Woman patient.
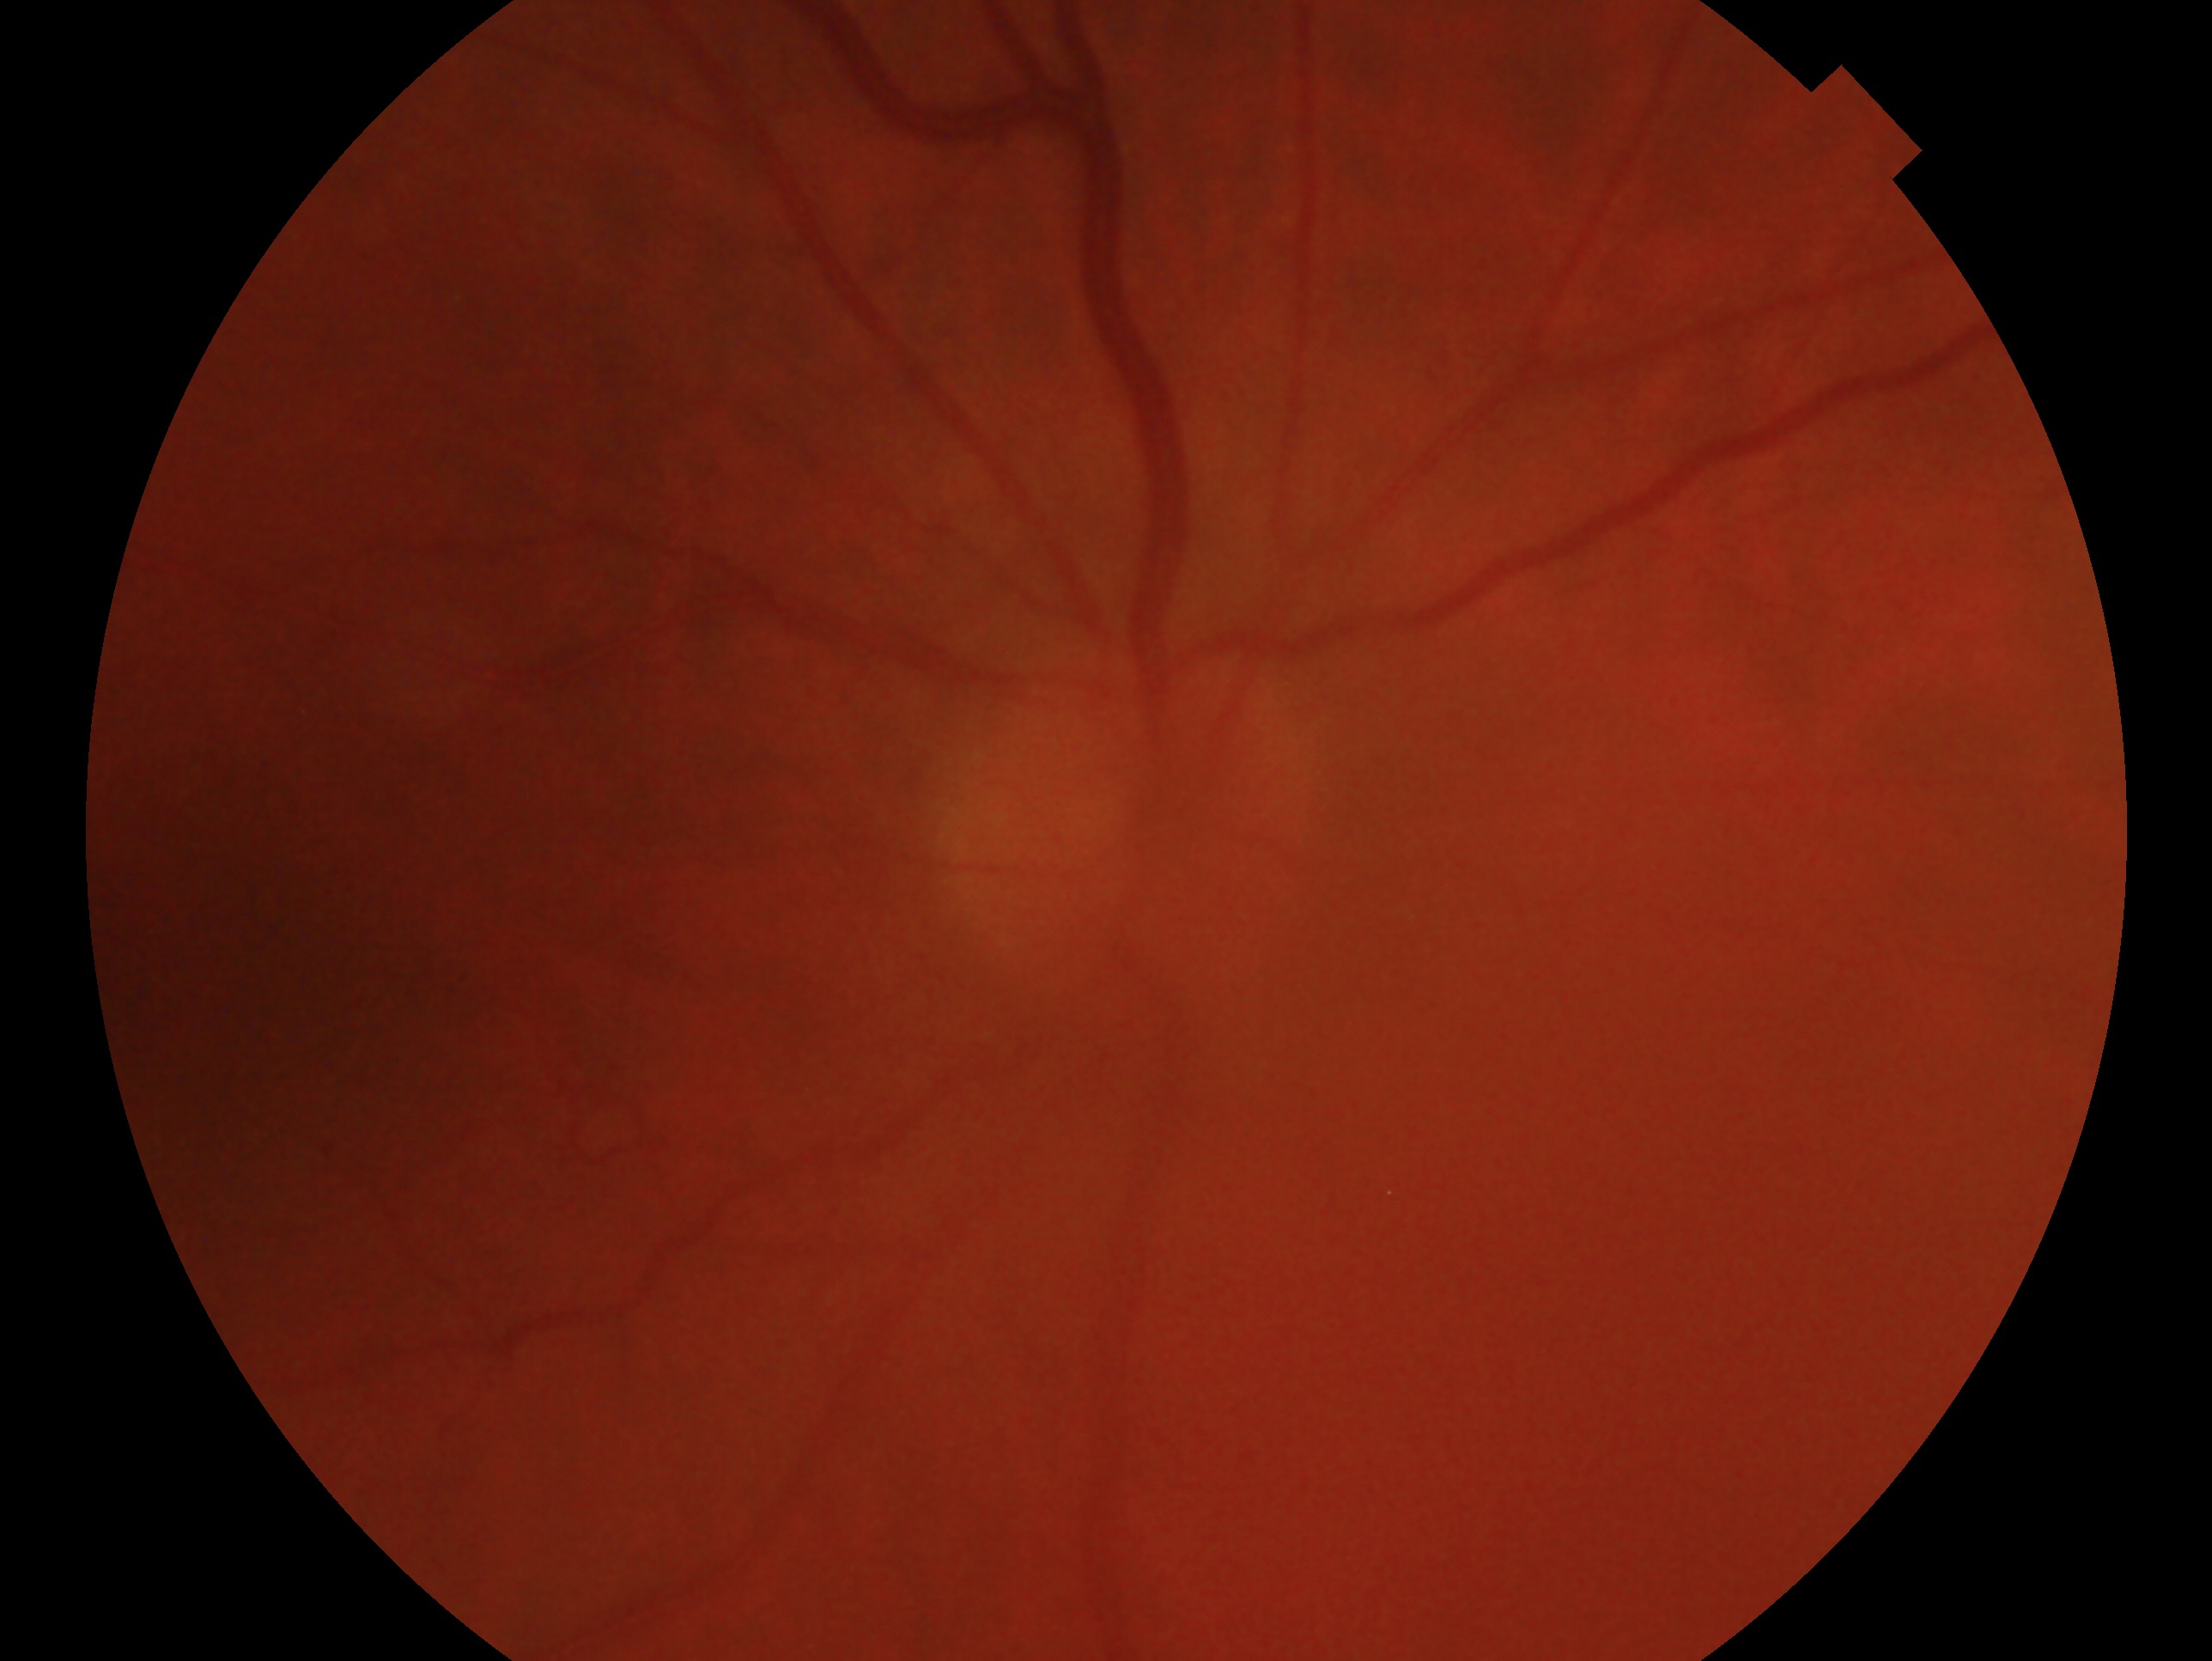
The image shows the right eye.
Impression: no glaucomatous findings.